2361 x 1568 pixels. 50° field of view:
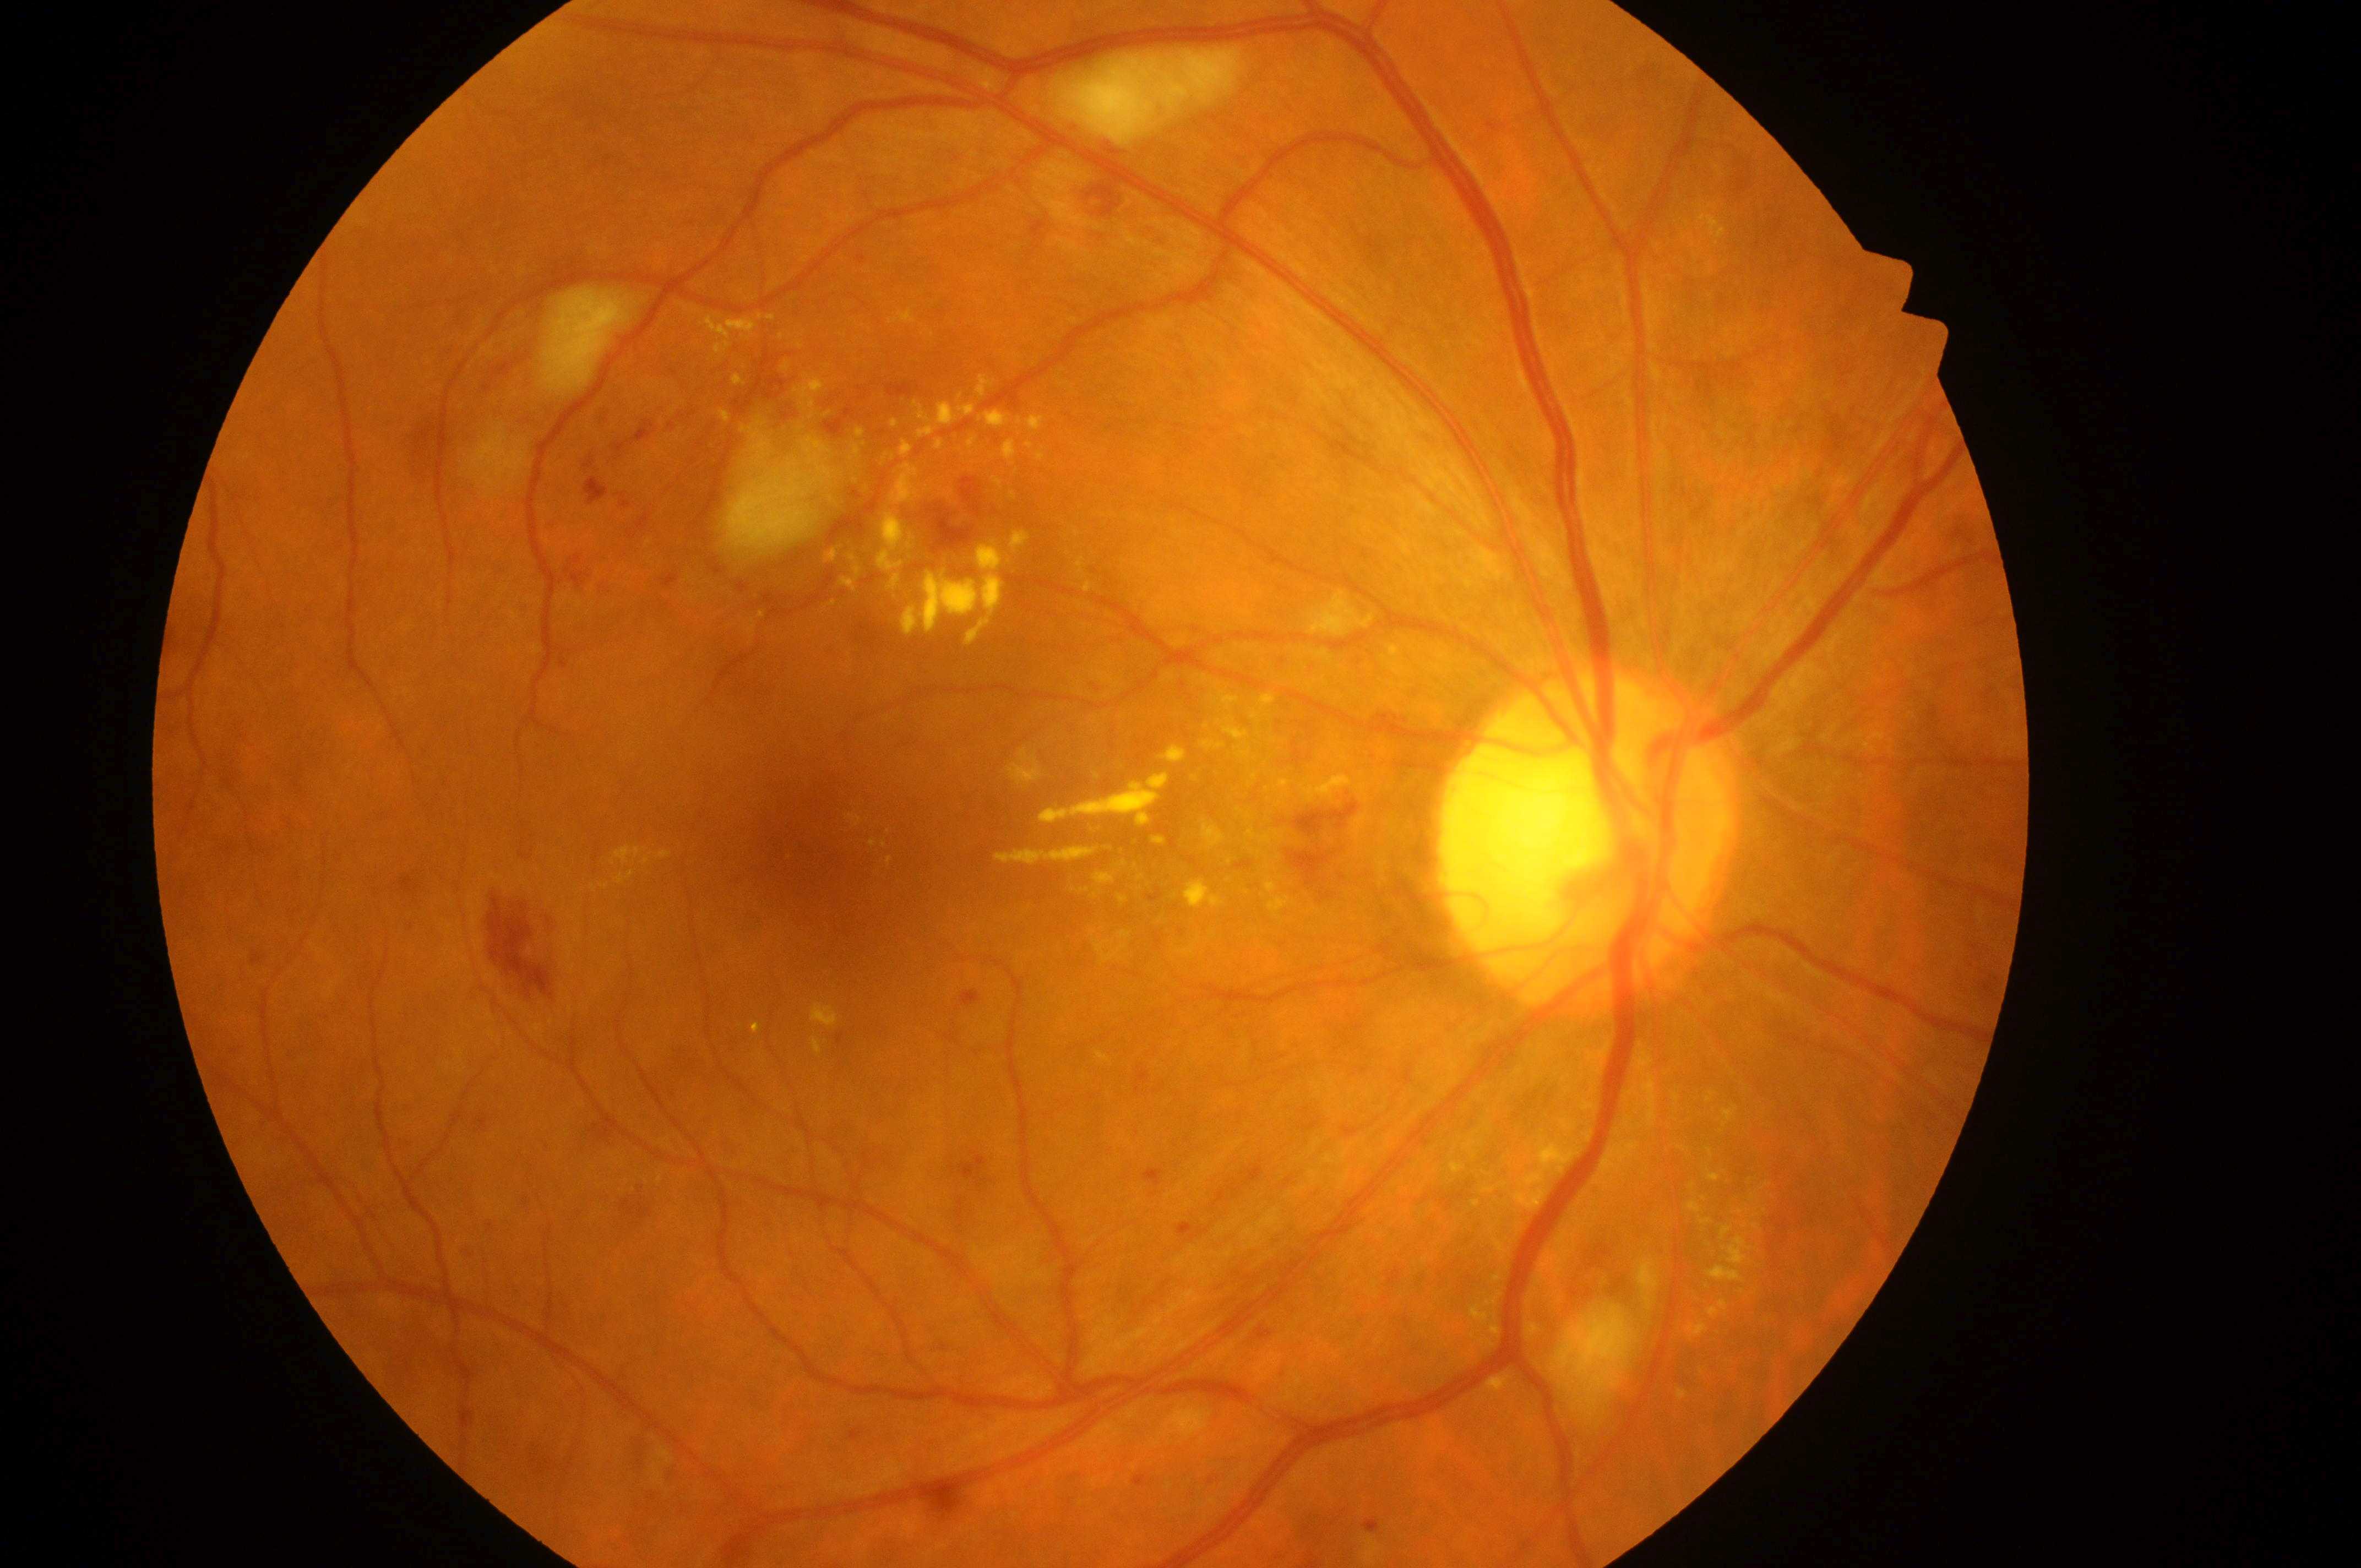 The optic disc is at (x: 1574, y: 850). DR class: non-proliferative diabetic retinopathy. Eye: right eye. DME risk is high risk (grade 2). DR is grade 2 (moderate NPDR). The macular center is at (x: 844, y: 847).